1932 x 1932 pixels; fundus photo.
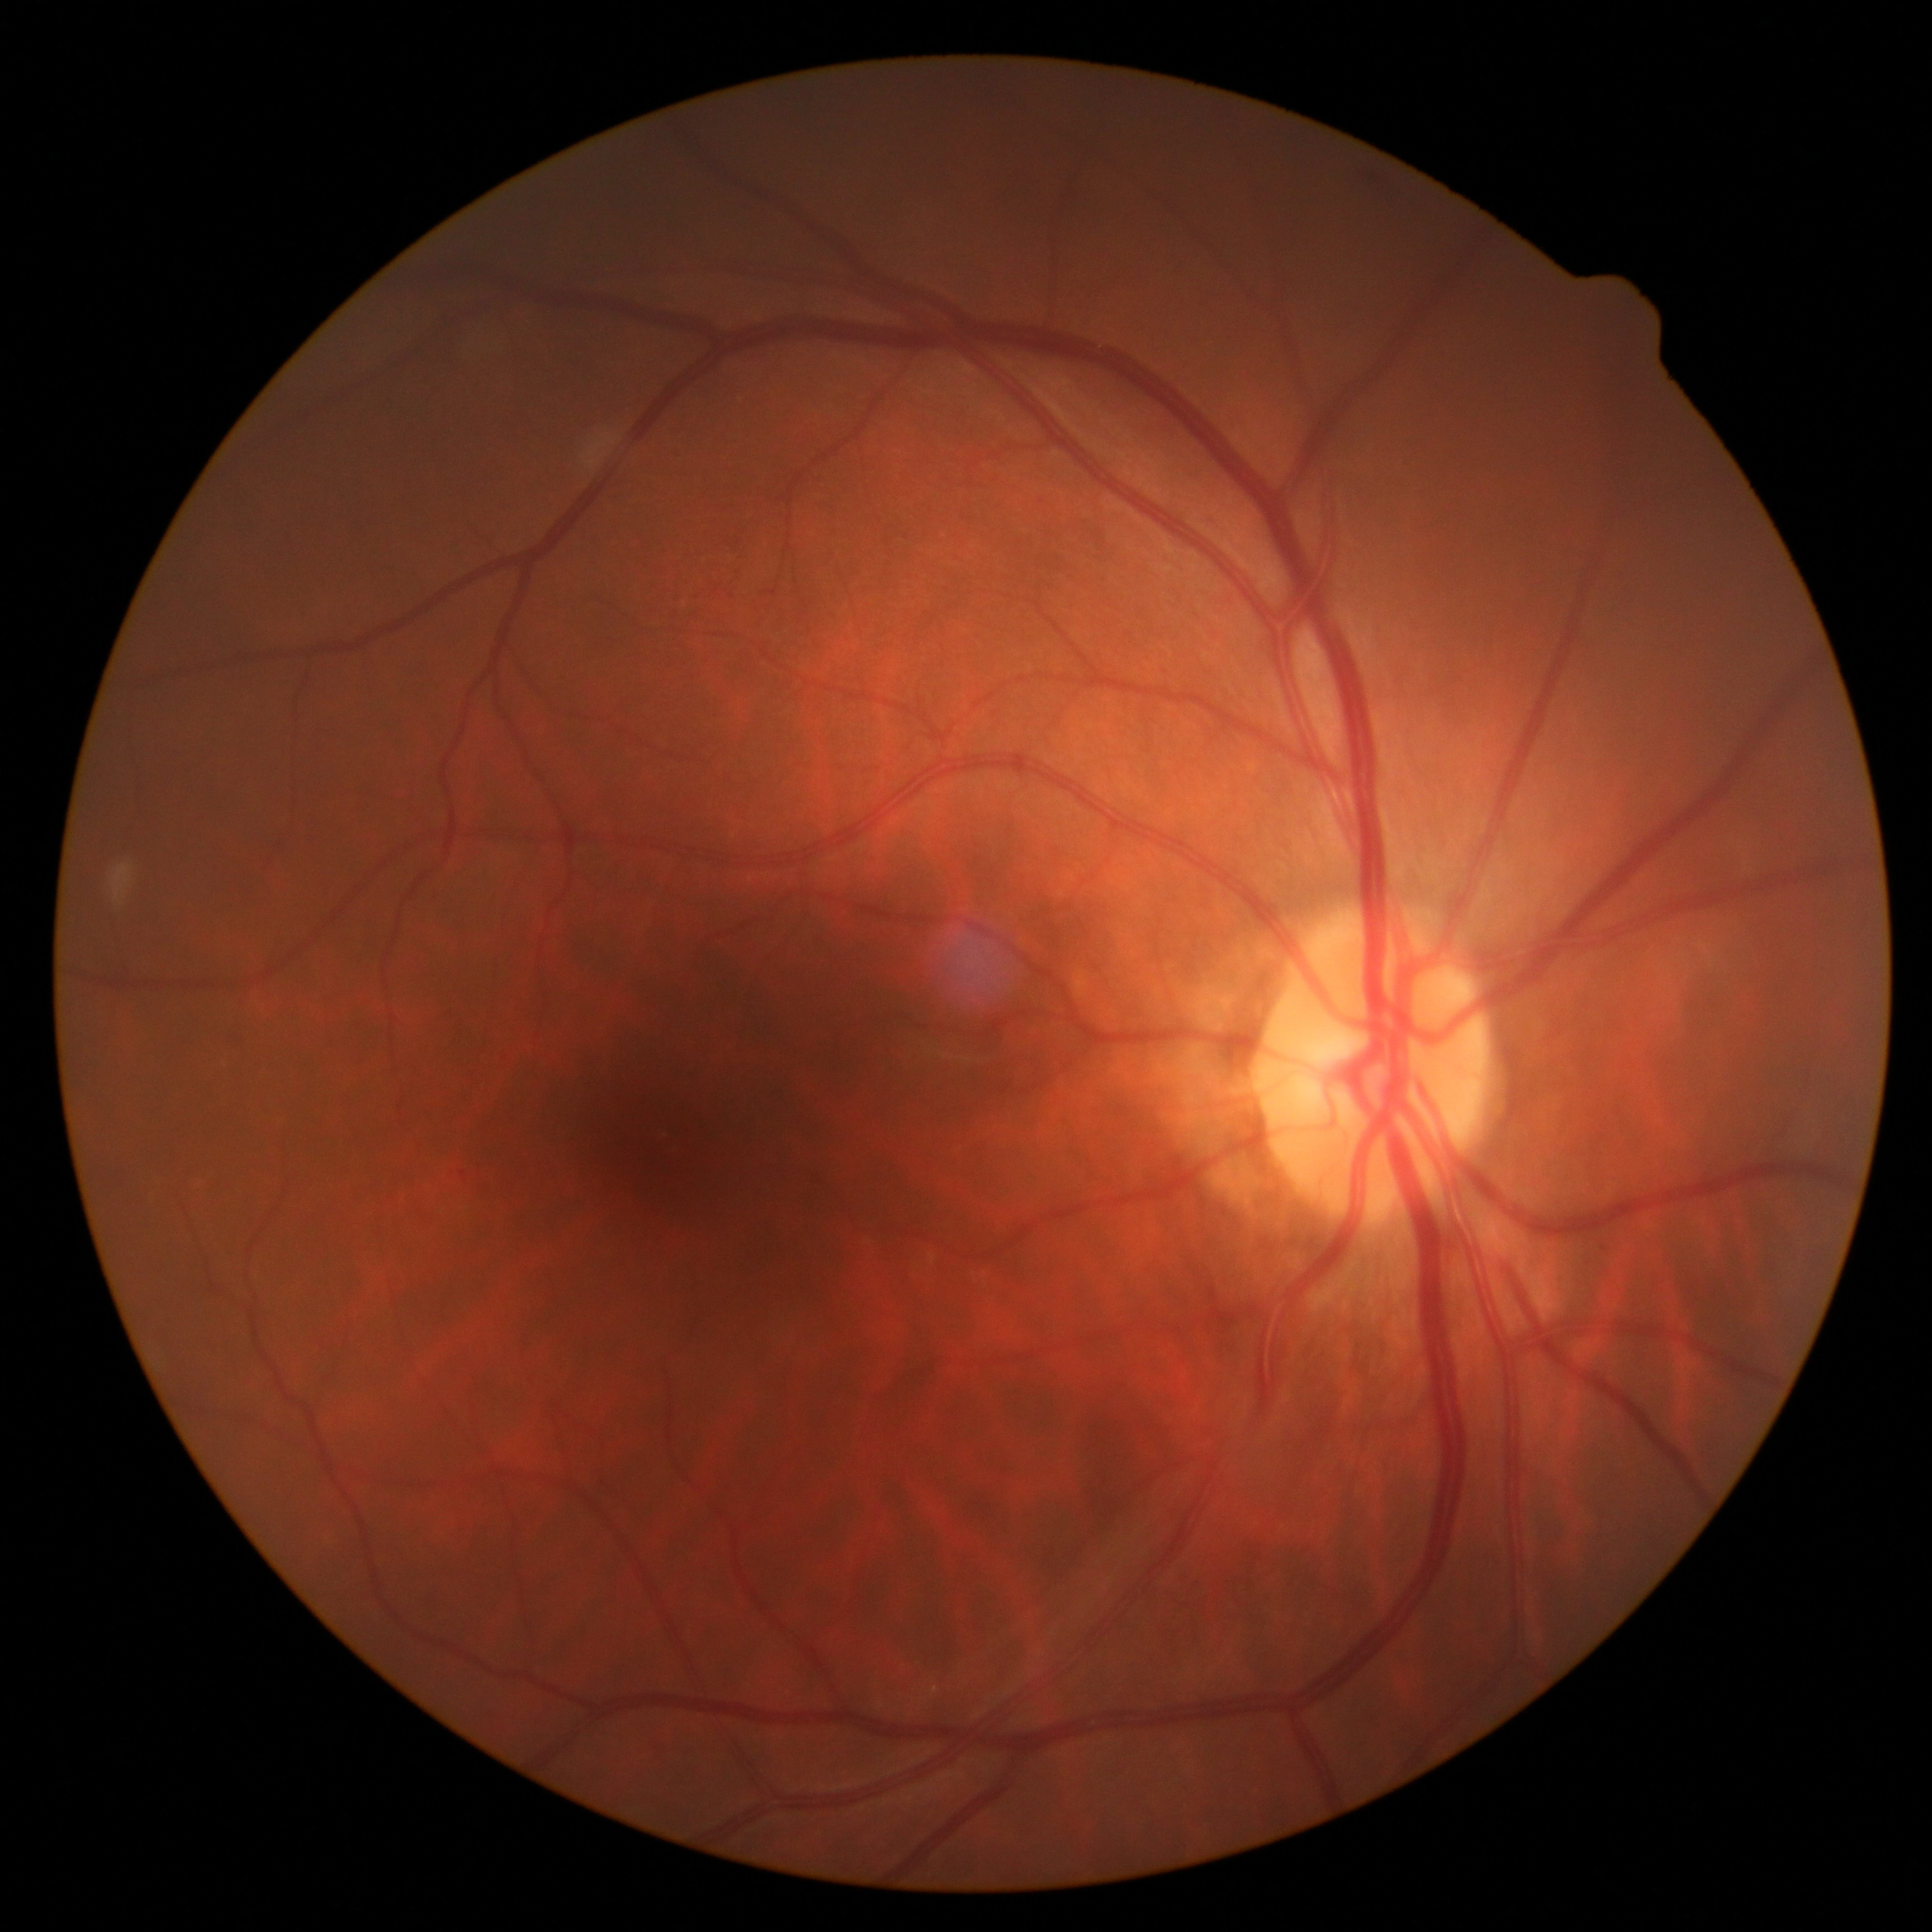
DR stage=grade 0 (no apparent retinopathy) — no visible signs of diabetic retinopathy.